FOV: 50 degrees; macula-centered field.
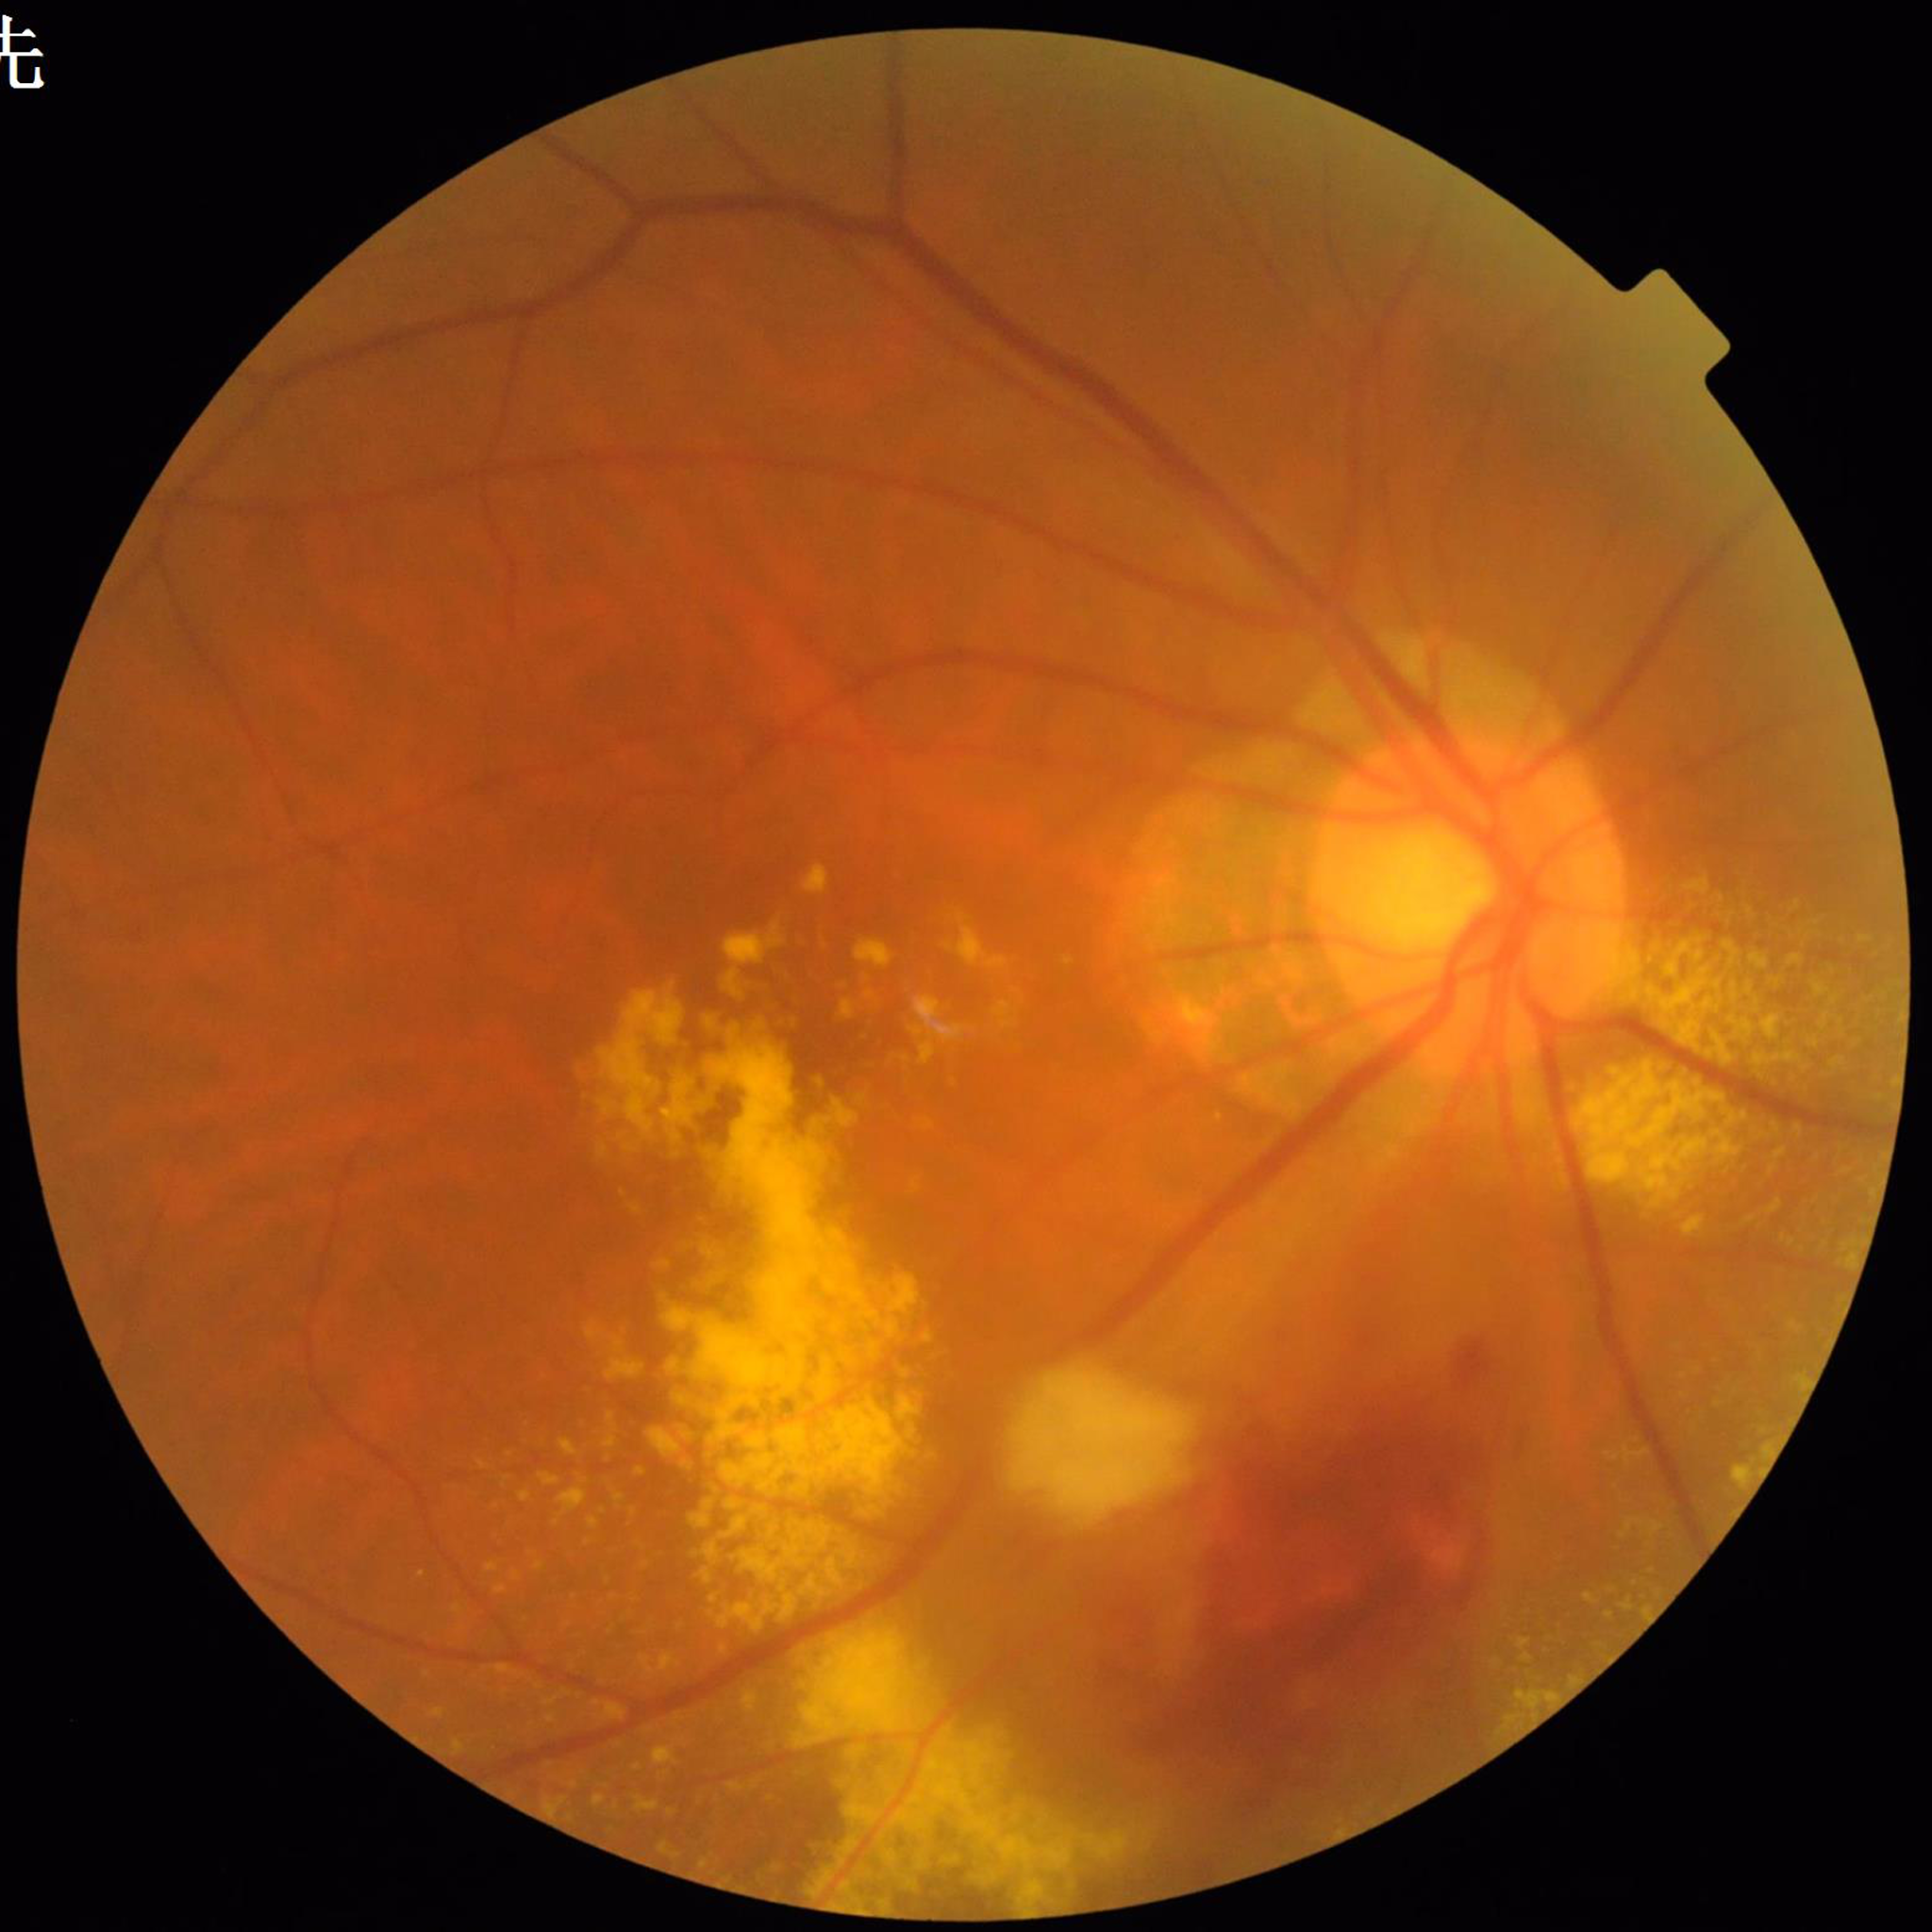 Automated quality assessment: no concerns identified.
Retinal fundus photograph from a patient with age-related macular degeneration.